763 x 716 pixels
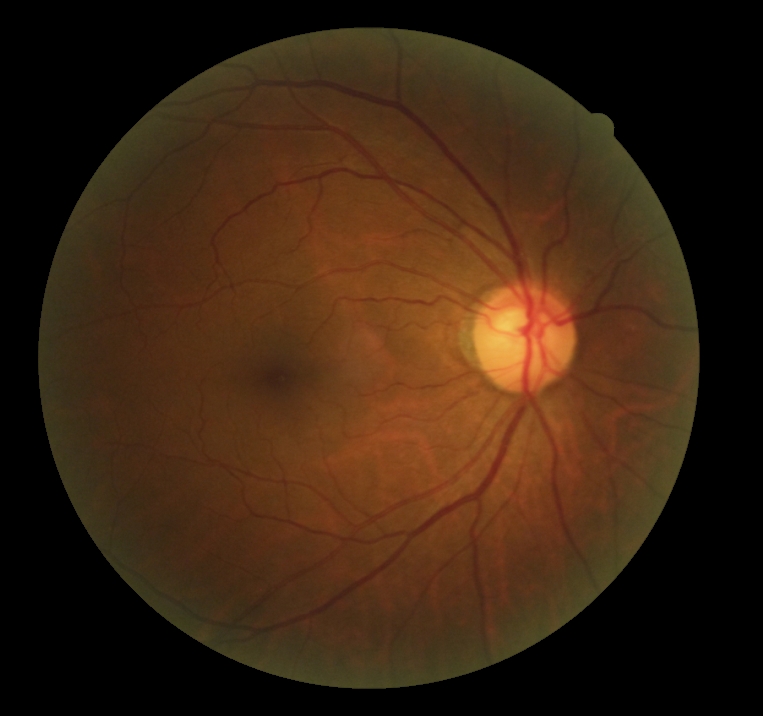 Diabetic retinopathy (DR) is grade 0 (no apparent retinopathy) — no visible signs of diabetic retinopathy.